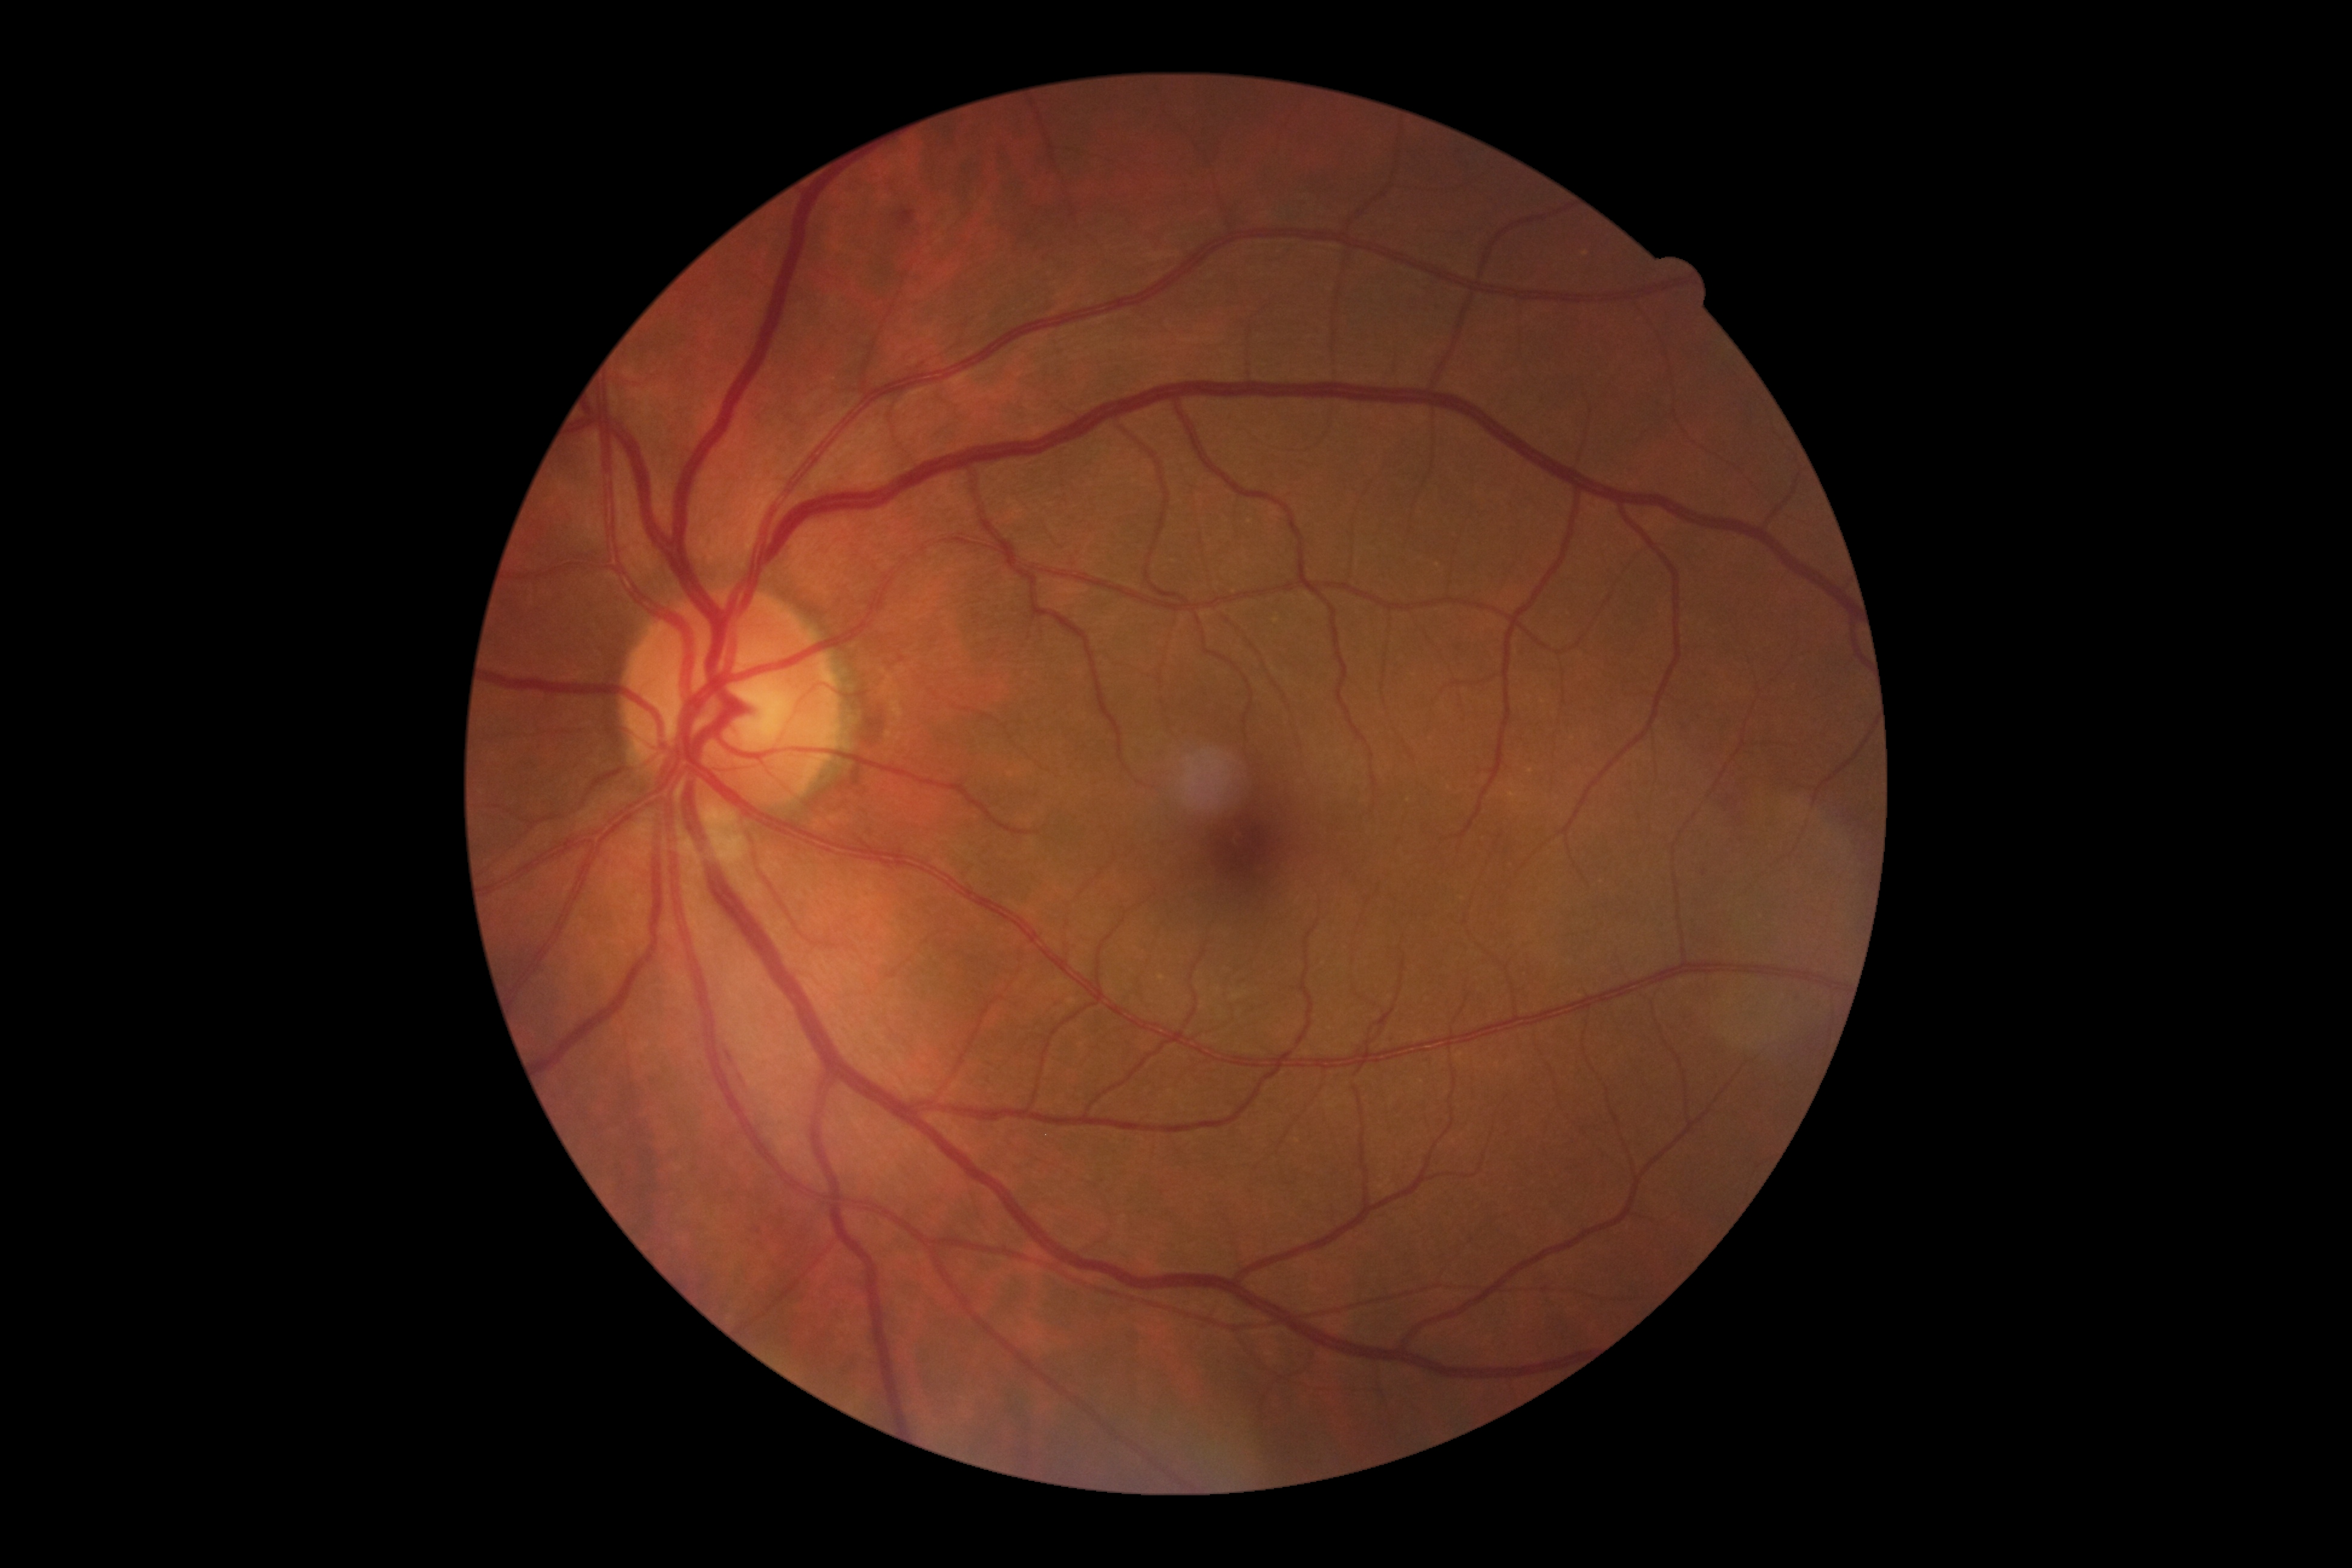
DR is moderate NPDR (grade 2).